Posterior pole color fundus photograph
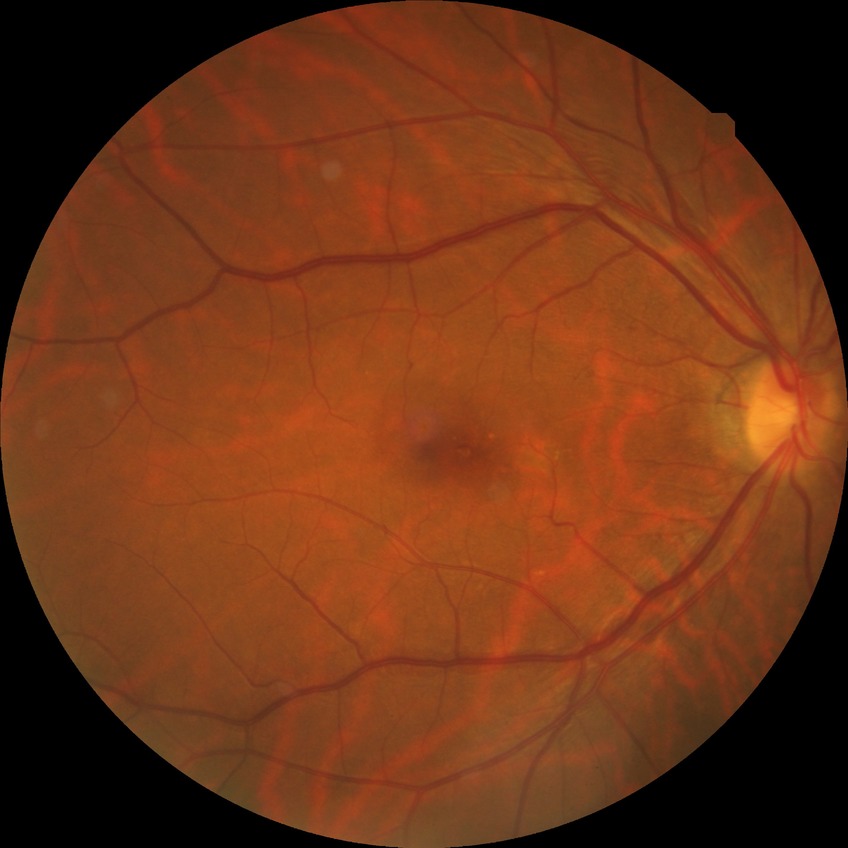

– diabetic retinopathy stage — simple diabetic retinopathy